Posterior pole color fundus photograph, nonmydriatic fundus photograph, 45° field of view — 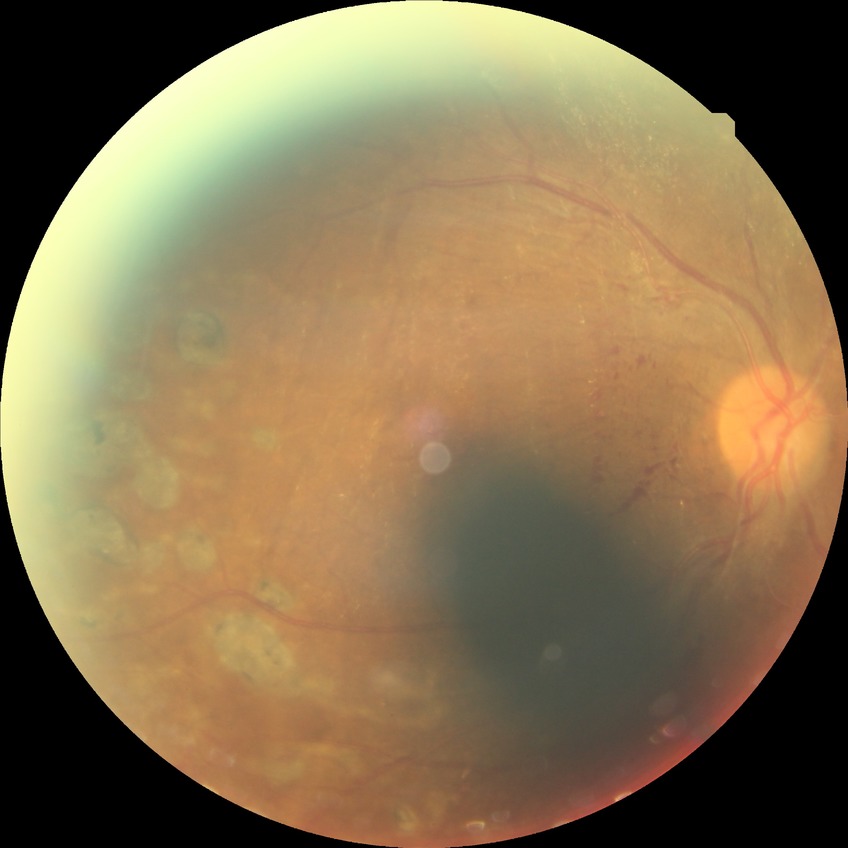
Diabetic retinopathy (DR) is proliferative diabetic retinopathy (PDR).